1380 x 1382 pixels
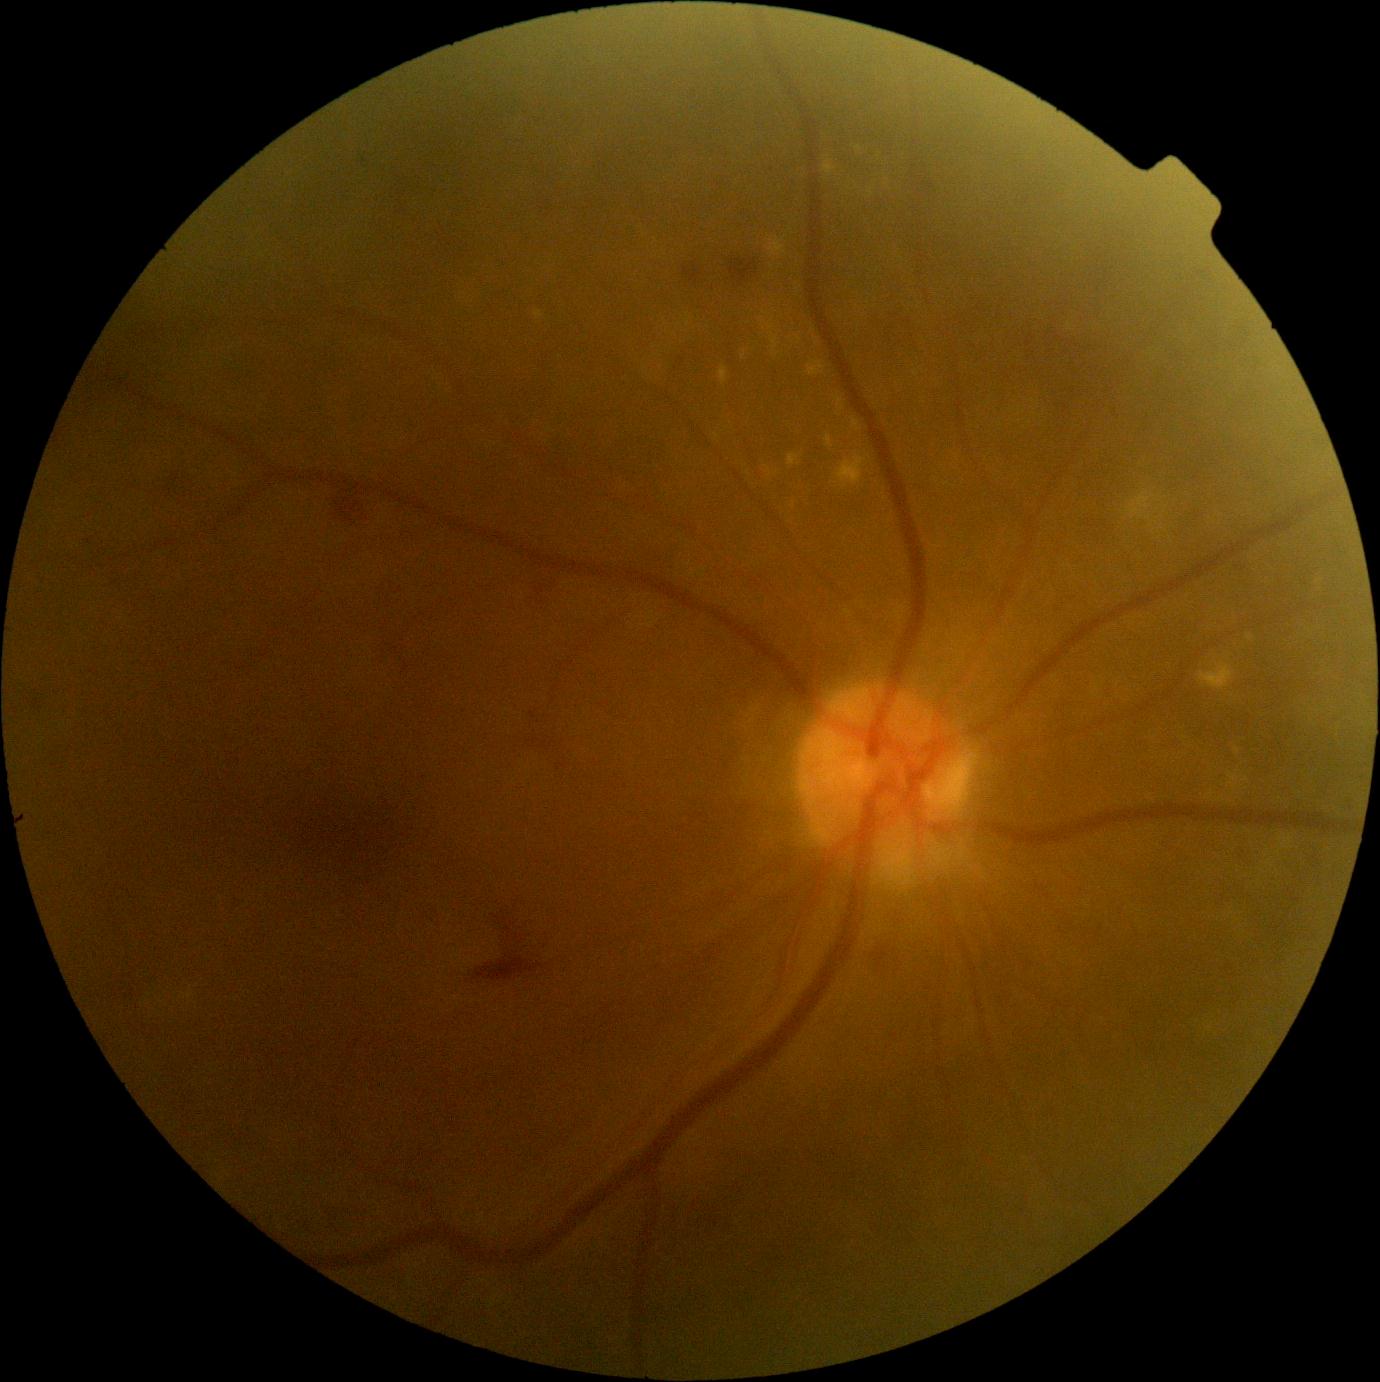

Diabetic retinopathy (DR): 2
A subset of detected lesions:
- Smaller MAs around (365,162)
- hemorrhages (HEs): [531, 710, 542, 722]; [682, 266, 700, 285]; [472, 907, 546, 981]; [533, 580, 557, 599]; [731, 259, 756, 282]; [168, 468, 188, 492]; [875, 943, 891, 973]; [335, 489, 371, 516]
- hard exudates (EXs) (subset): [807, 360, 826, 376]; [535, 310, 543, 320]; [759, 319, 775, 331]; [1126, 492, 1155, 520]; [852, 418, 861, 432]; [1229, 772, 1240, 787]; [836, 456, 867, 489]; [767, 468, 772, 476]; [771, 336, 780, 354]
- Smaller EXs around (799,338); (776,473); (764,327); (839,415); (859,149)
- soft exudates (SEs): none identified